CFP. 45° field of view. 848 x 848 pixels. Acquired with a NIDEK AFC-230. Nonmydriatic fundus photograph: 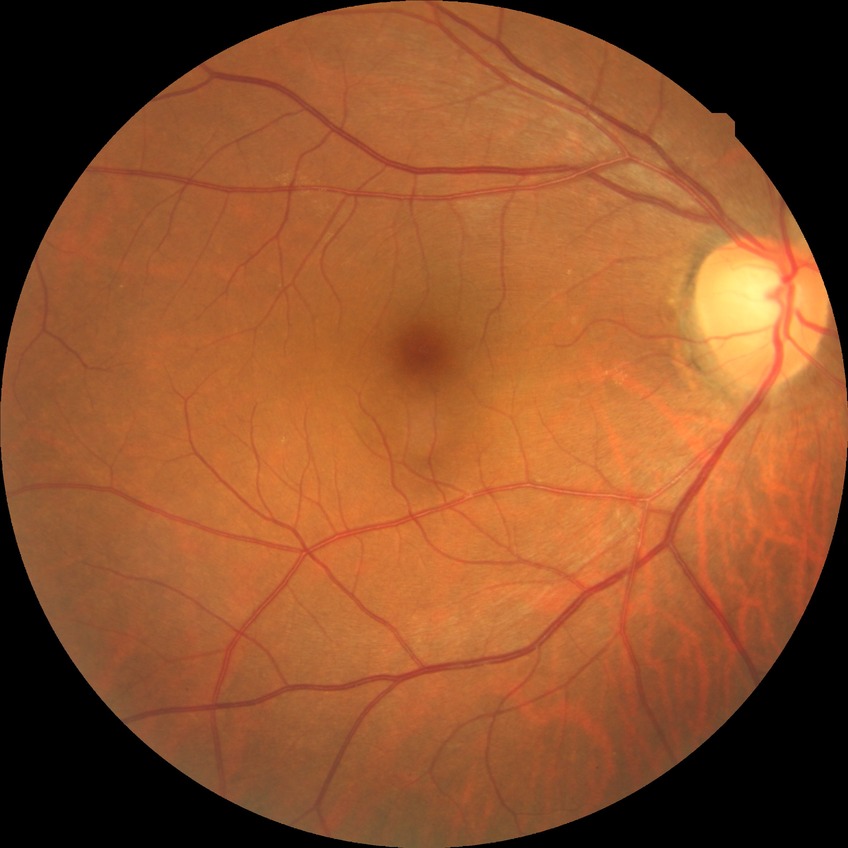
Diabetic retinopathy (DR) is no diabetic retinopathy (NDR).